Ultra-widefield (UWF) fundus image
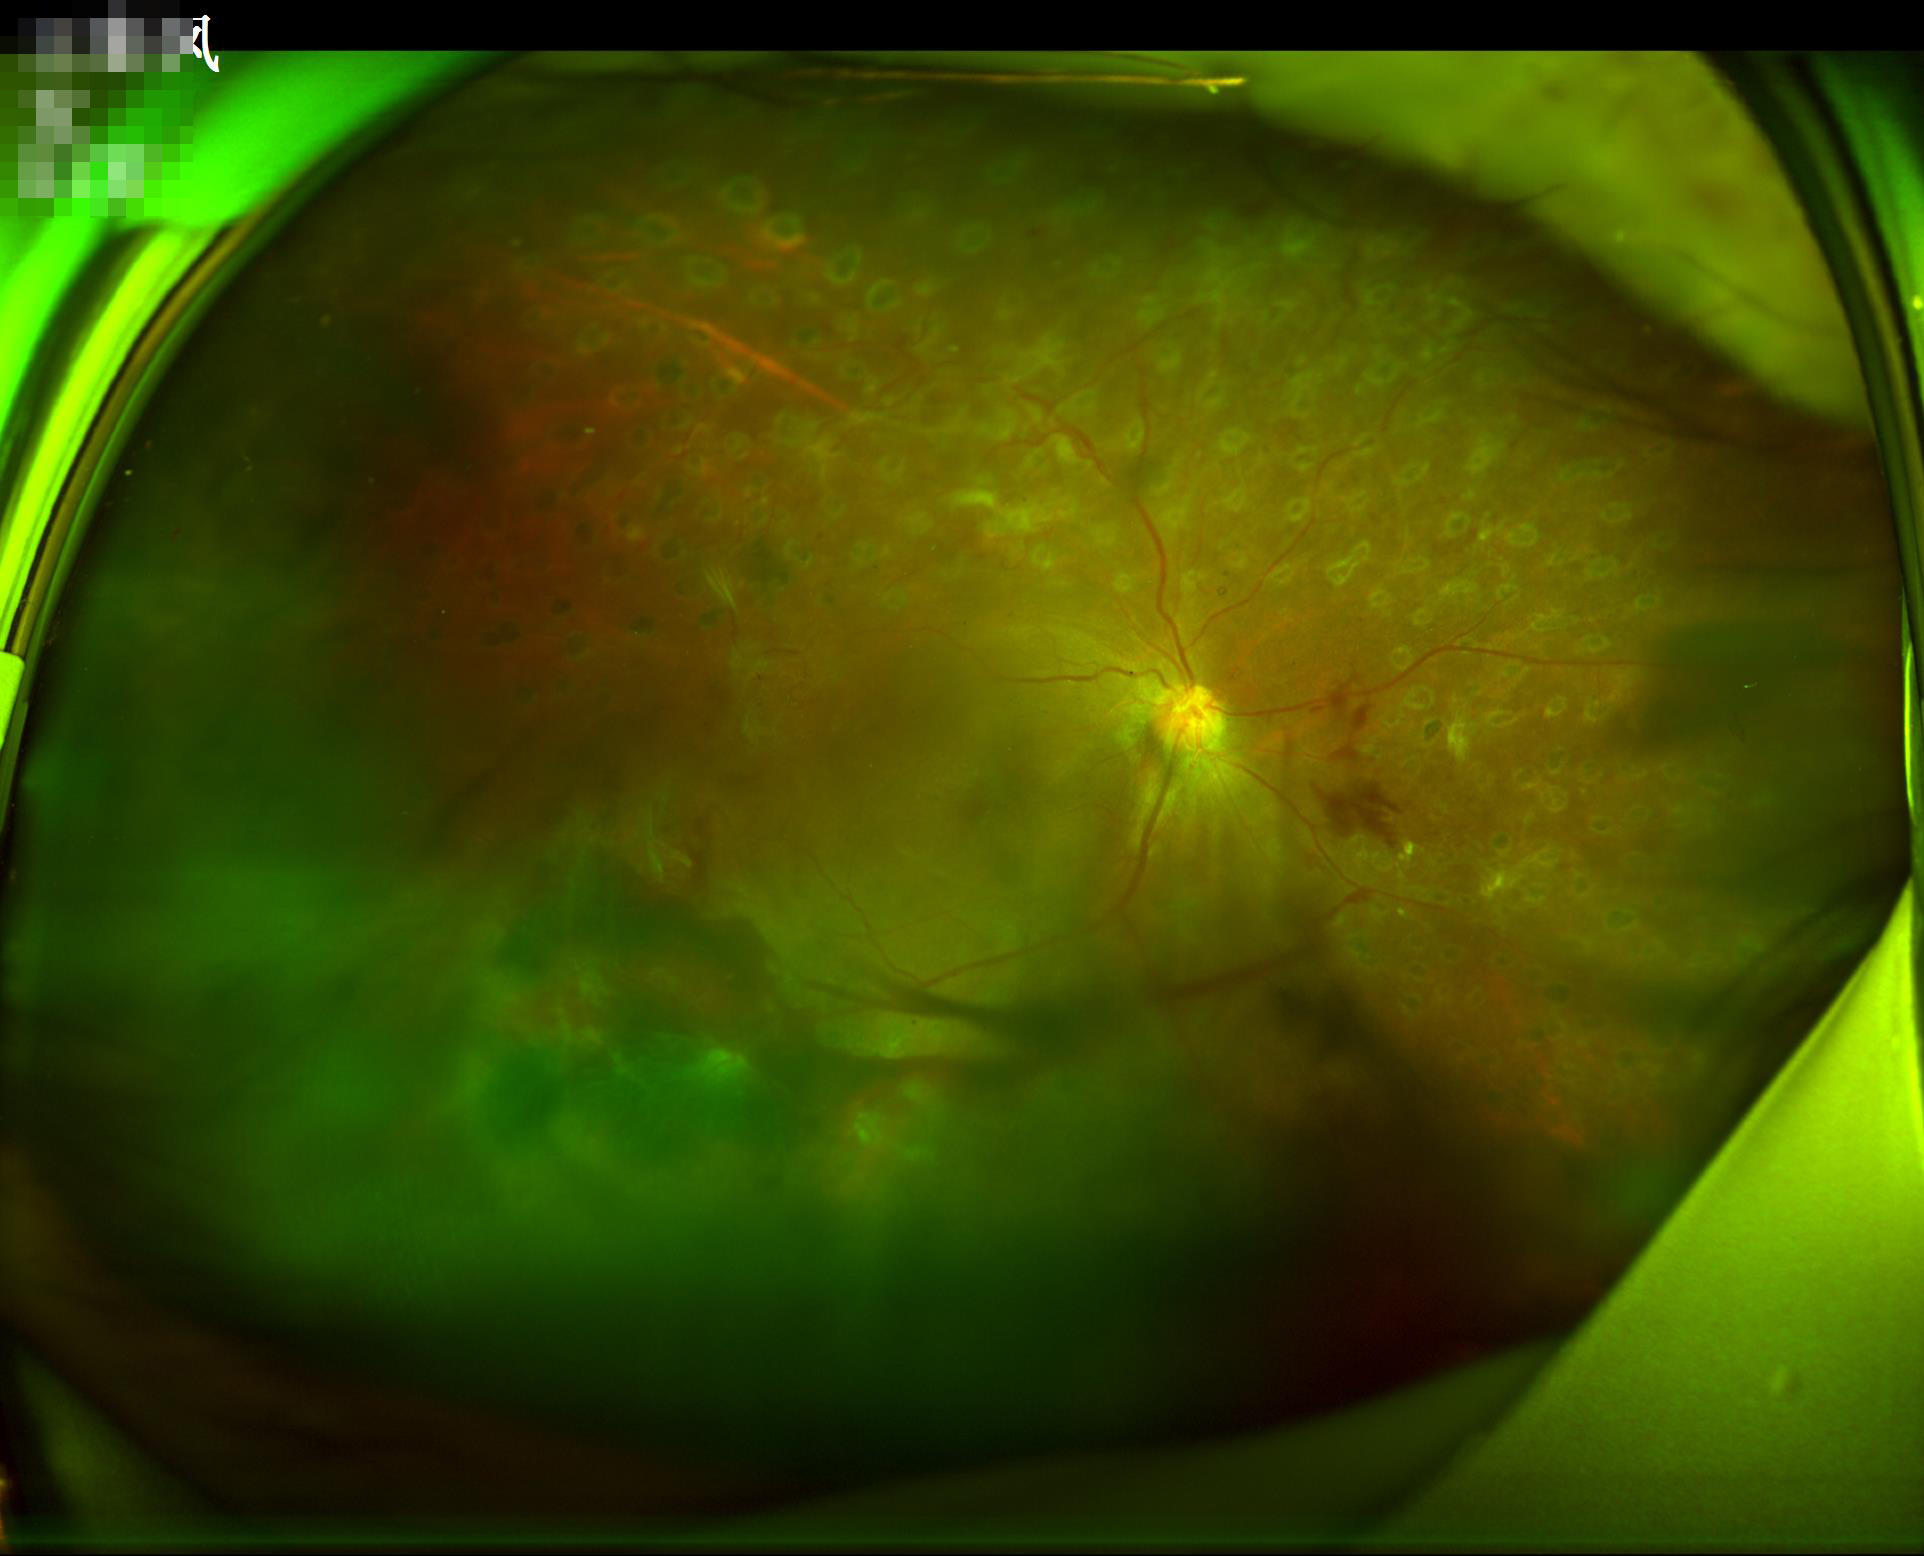 Image quality is inadequate for diagnostic use.
Illumination is uneven.
Out of focus; structures are indistinct.
Vessels and details are readily distinguishable.